2184x1690; color fundus image; 45° field of view
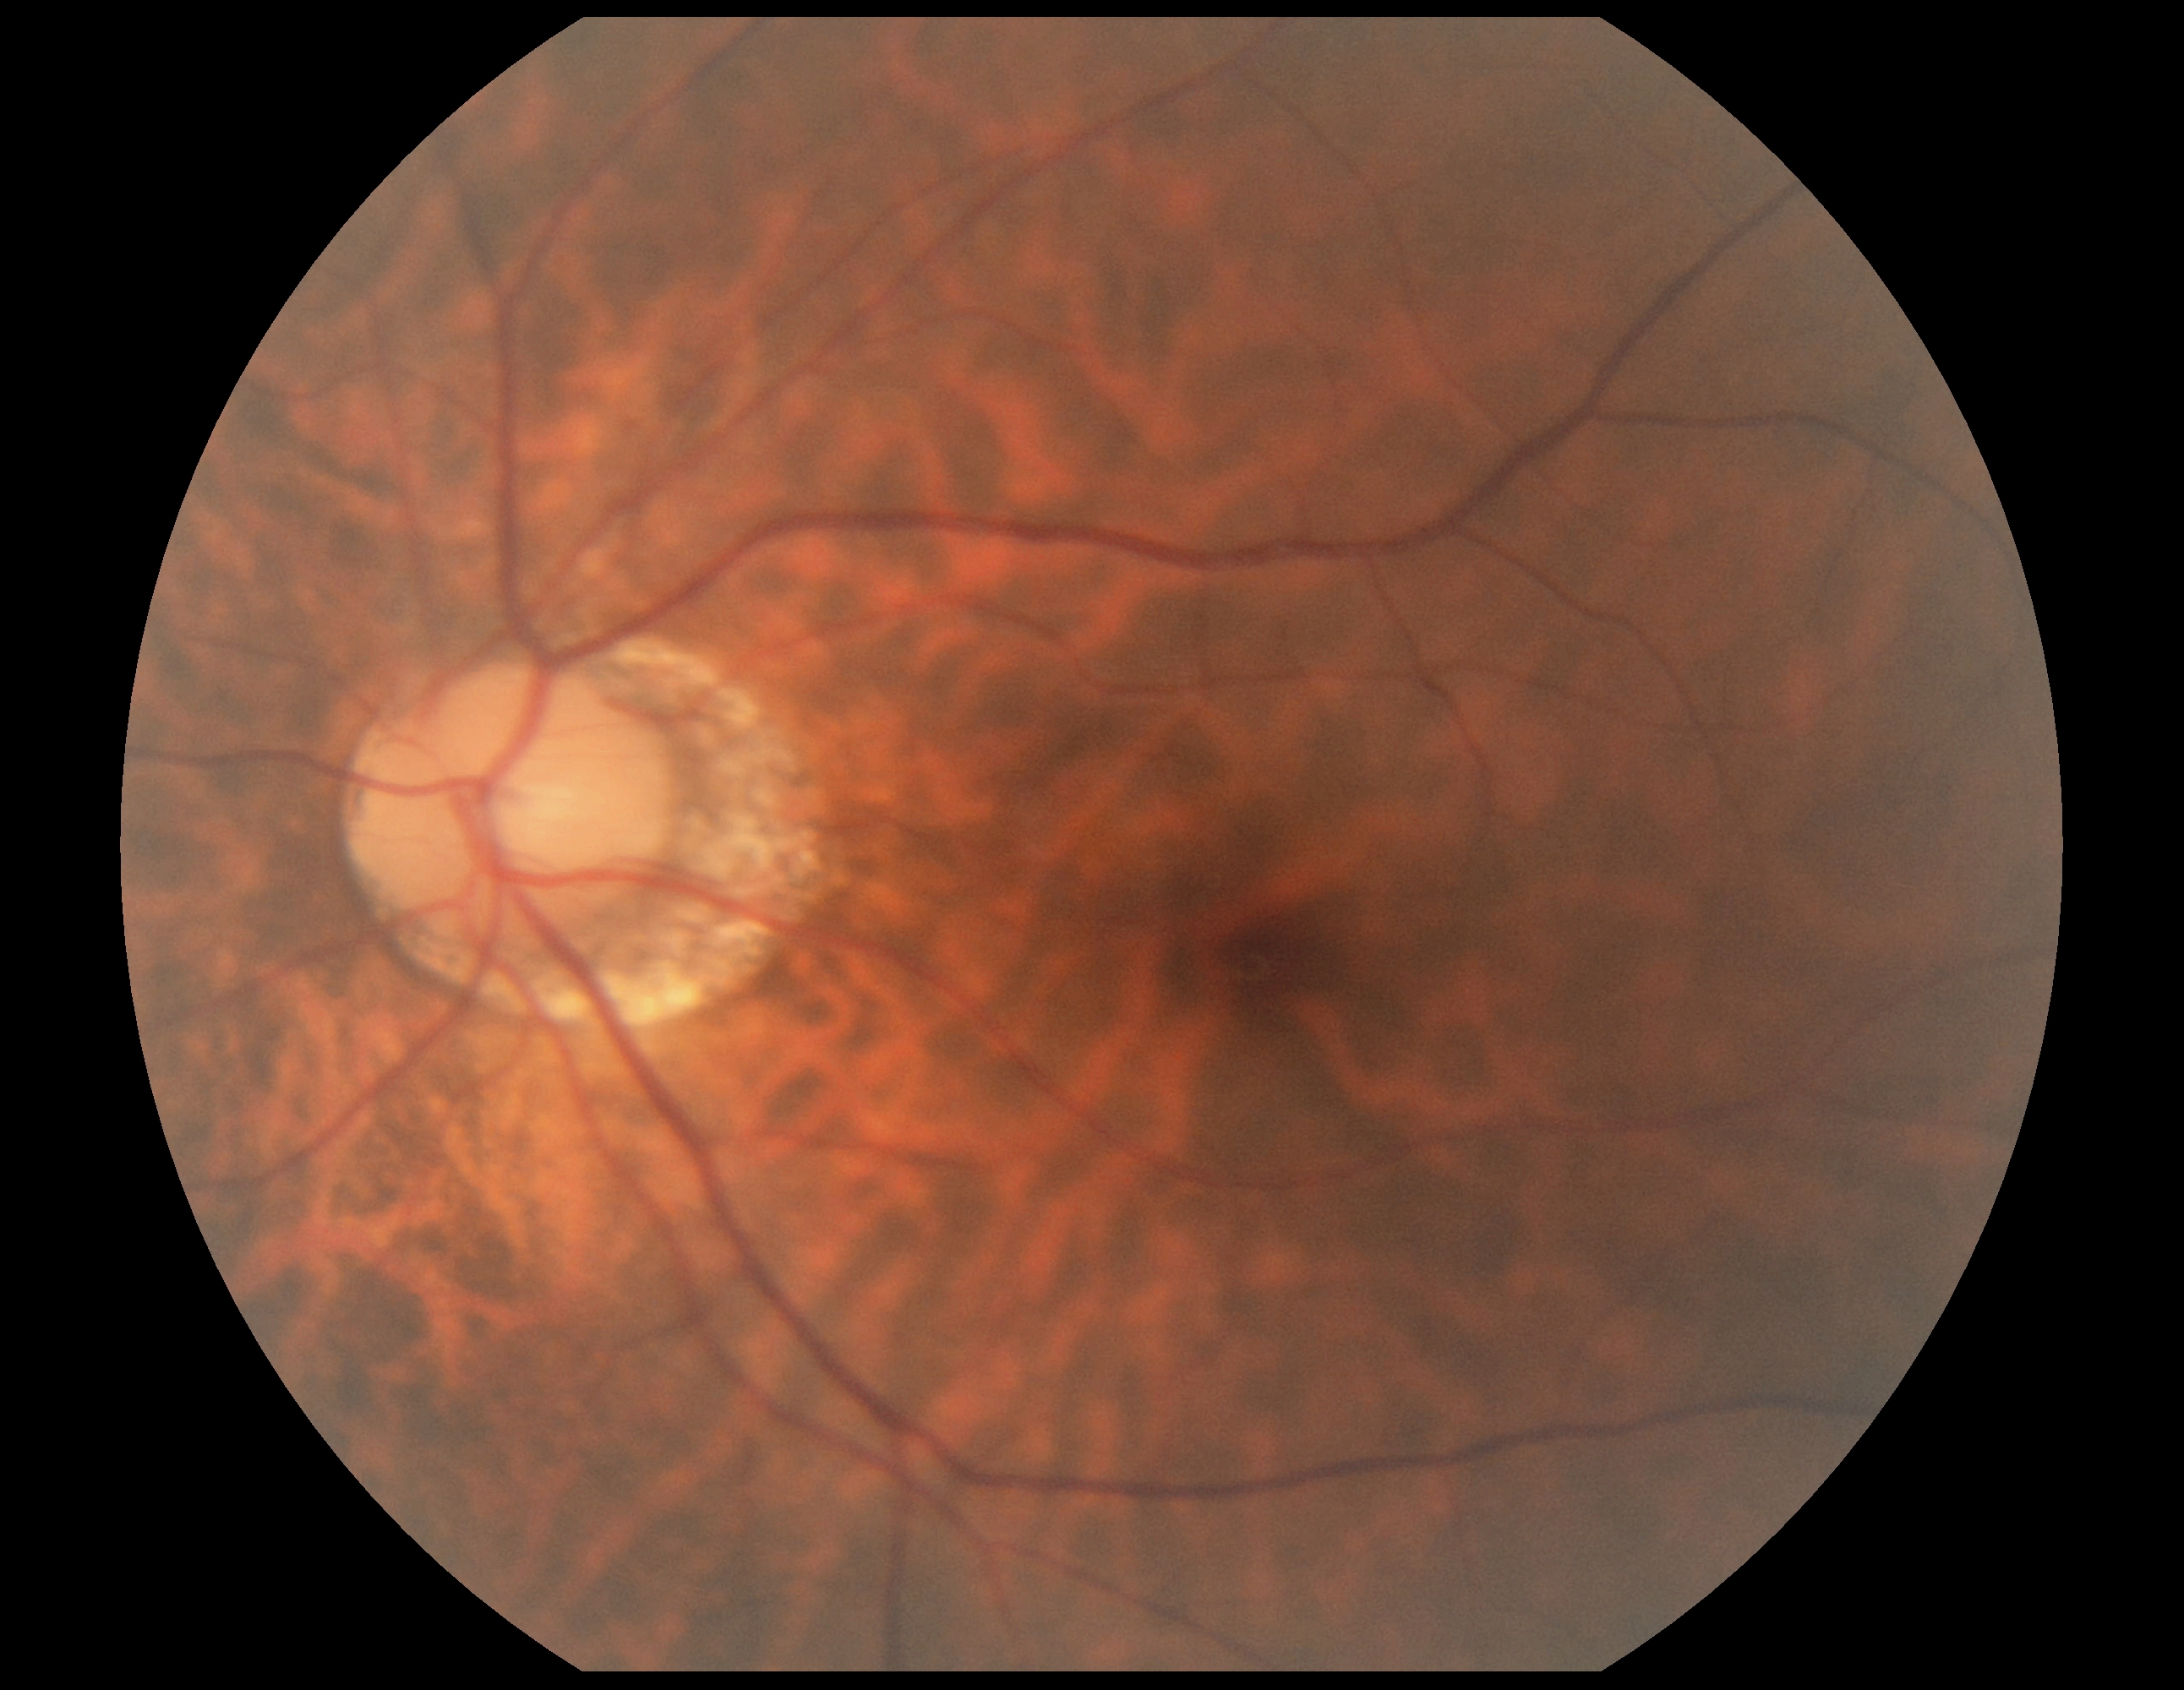 Retinopathy: no apparent retinopathy (grade 0).